1932x1910.
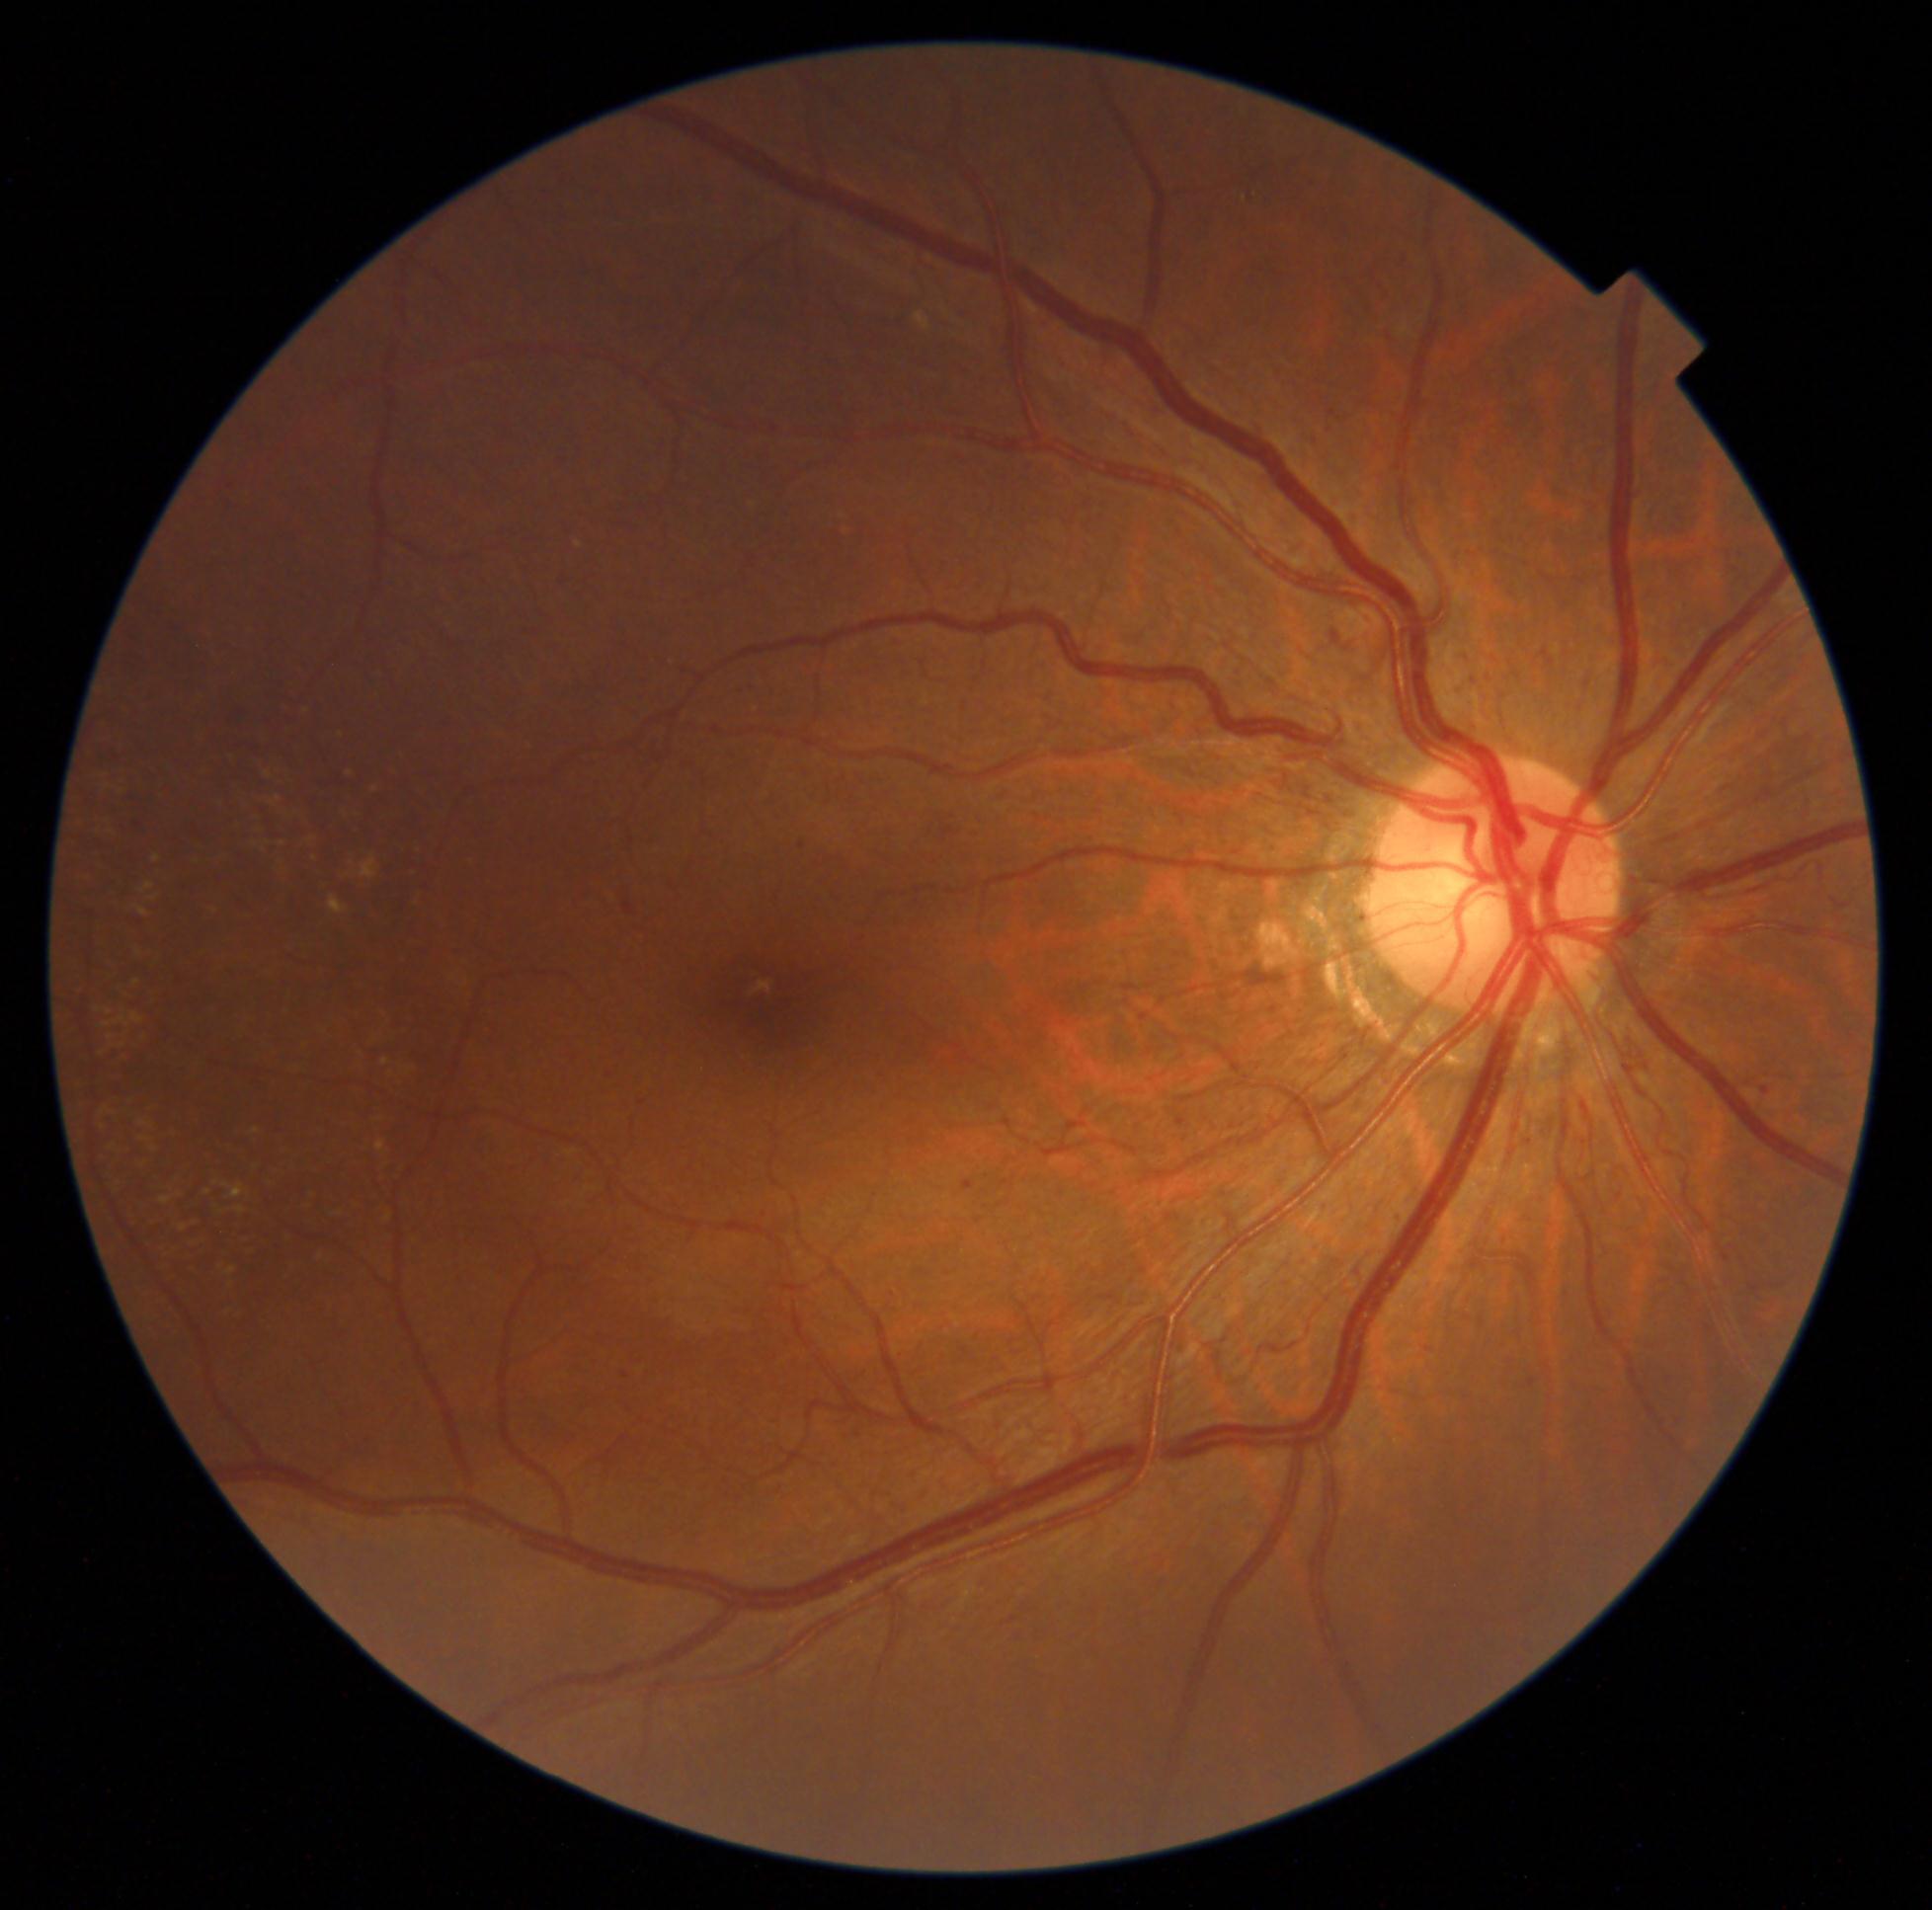 Diabetic retinopathy (DR): grade 1.